848 by 848 pixels · without pupil dilation · 45 degree fundus photograph · diabetic retinopathy graded by the modified Davis classification — 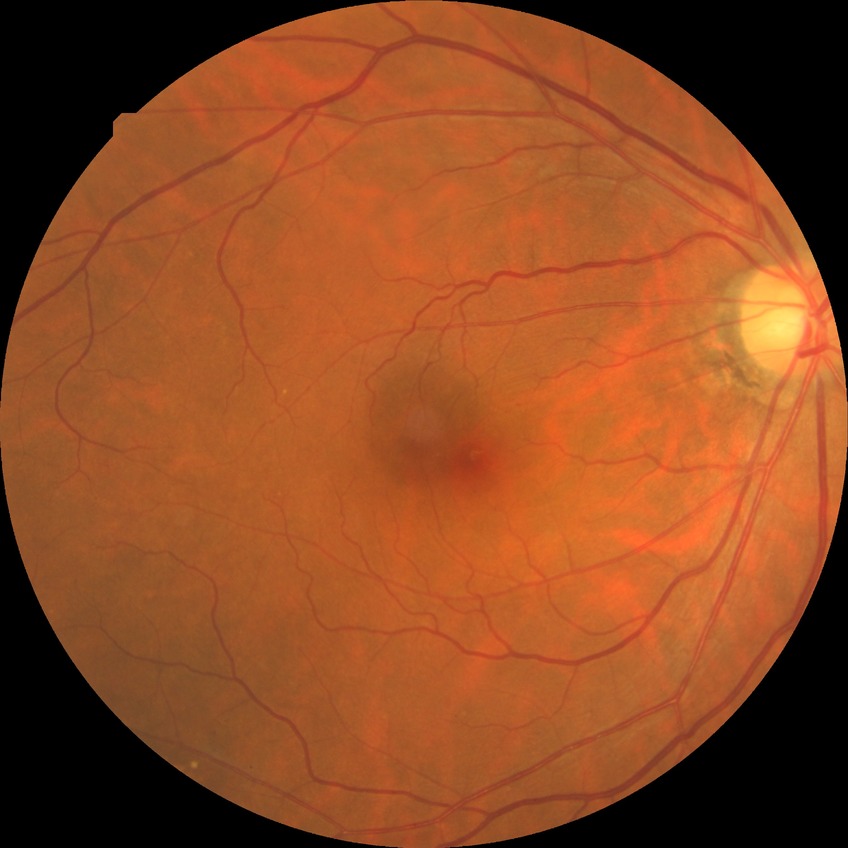

retinopathy grade = simple diabetic retinopathy.